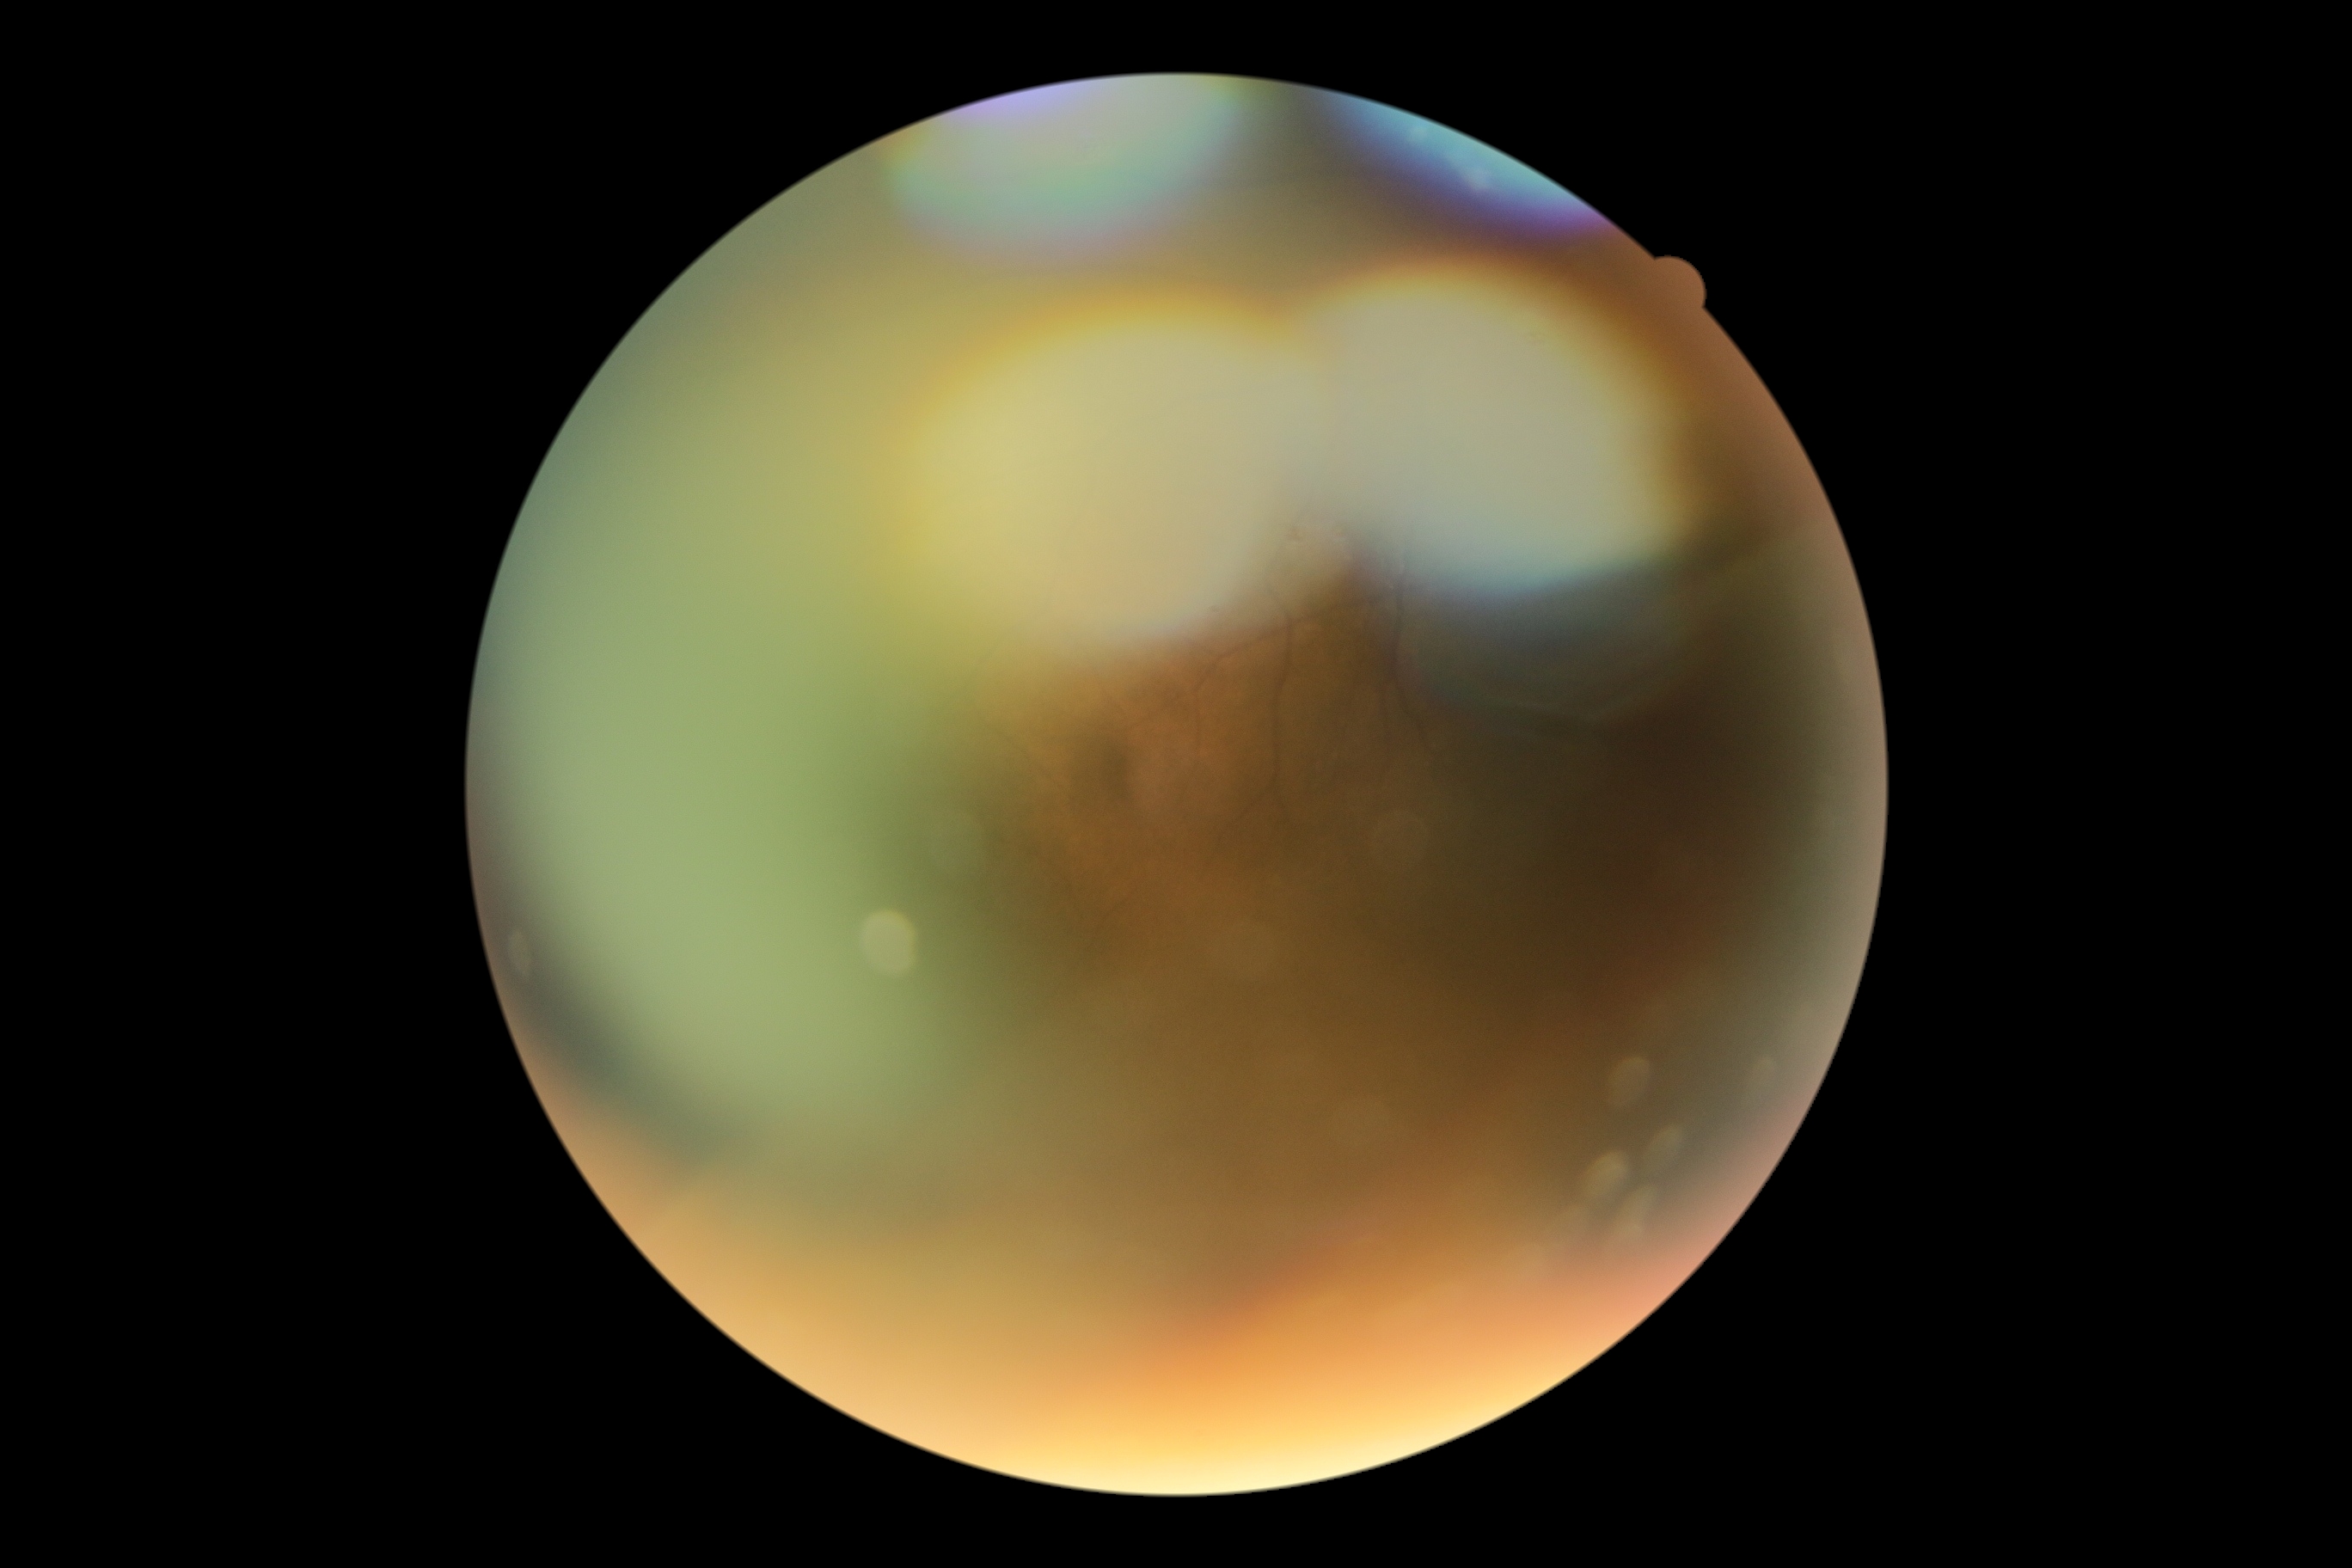

diabetic retinopathy (DR): ungradable due to poor image quality, image quality: insufficient for DR assessment.